2346 x 1568 pixels; CFP
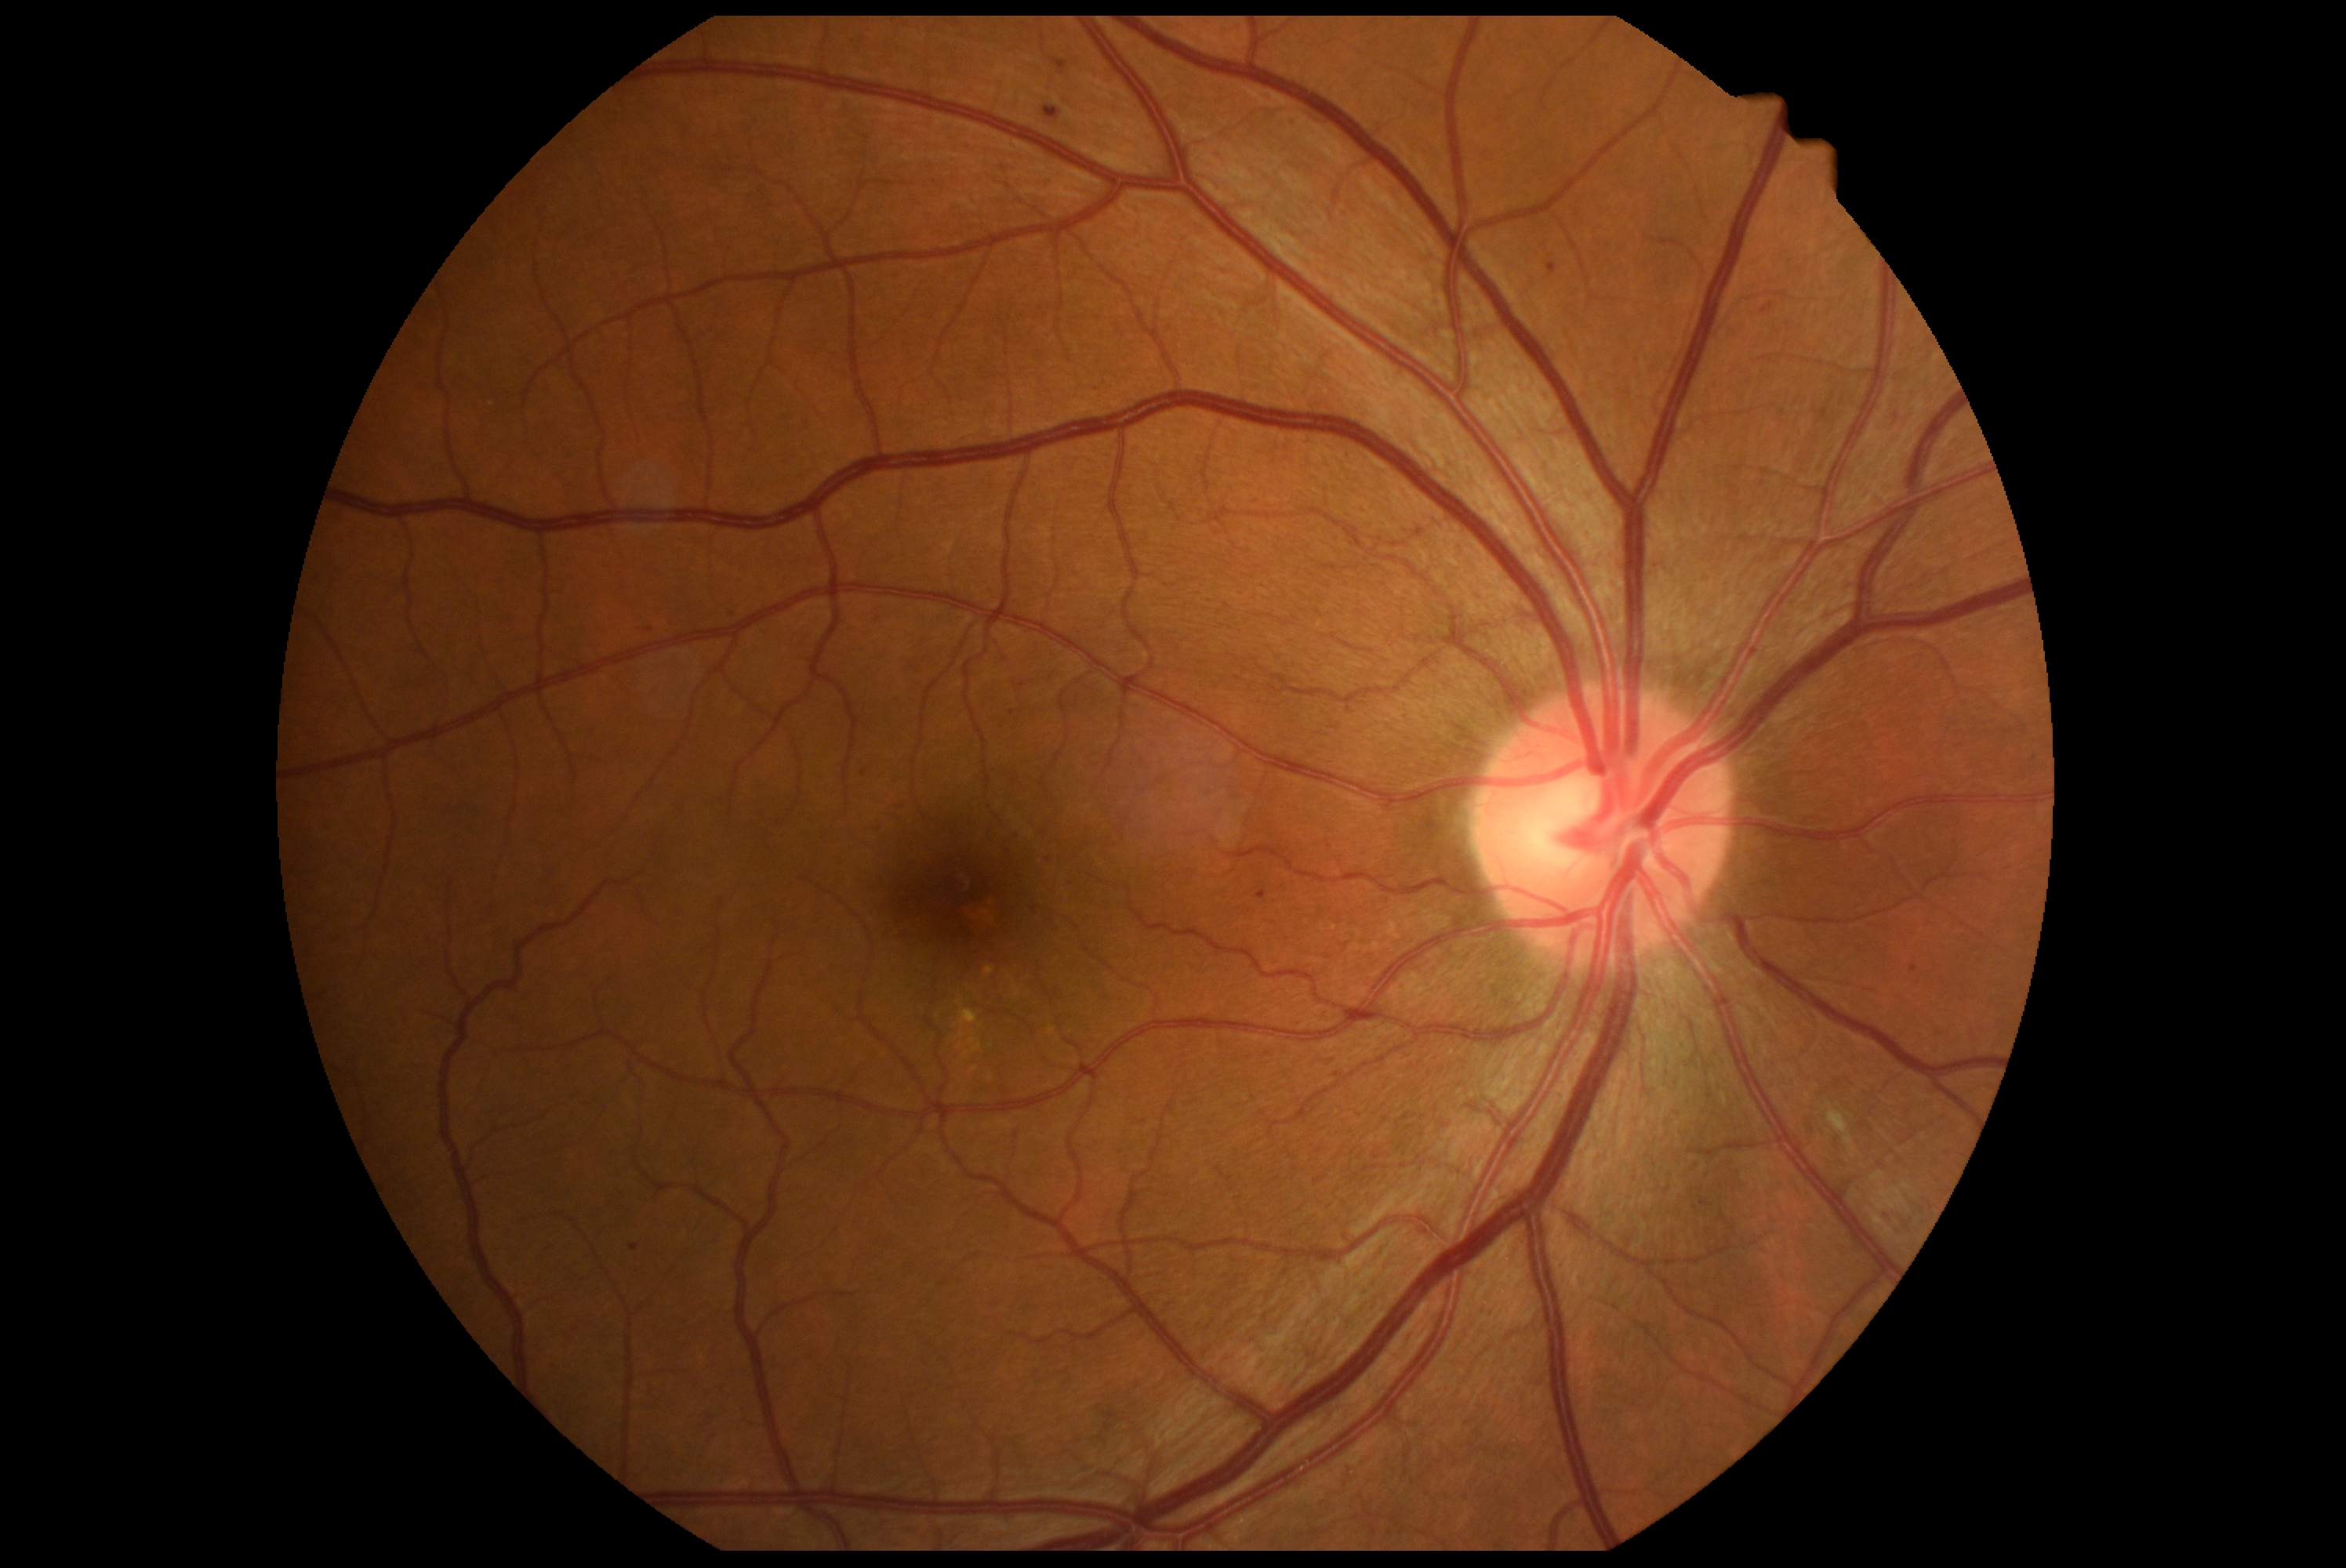
Diabetic retinopathy is 2 — more than just microaneurysms but less than severe NPDR.